Nonmydriatic fundus photograph · acquired with a NIDEK AFC-230 · 848 by 848 pixels · 45° field of view:
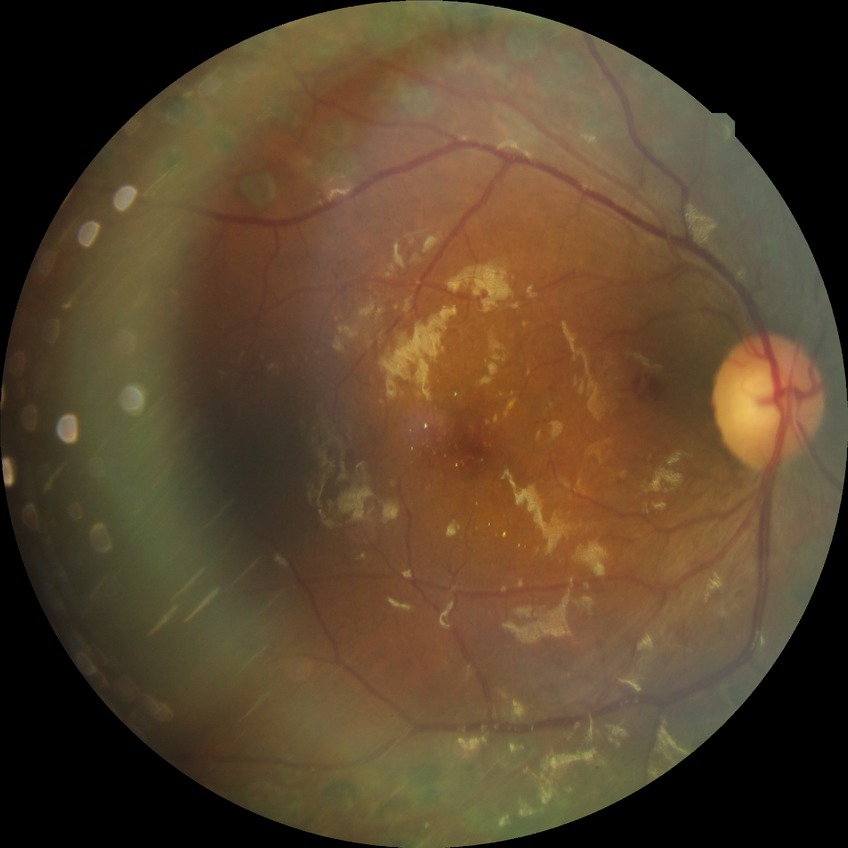 diabetic retinopathy (DR)@PDR (proliferative diabetic retinopathy).